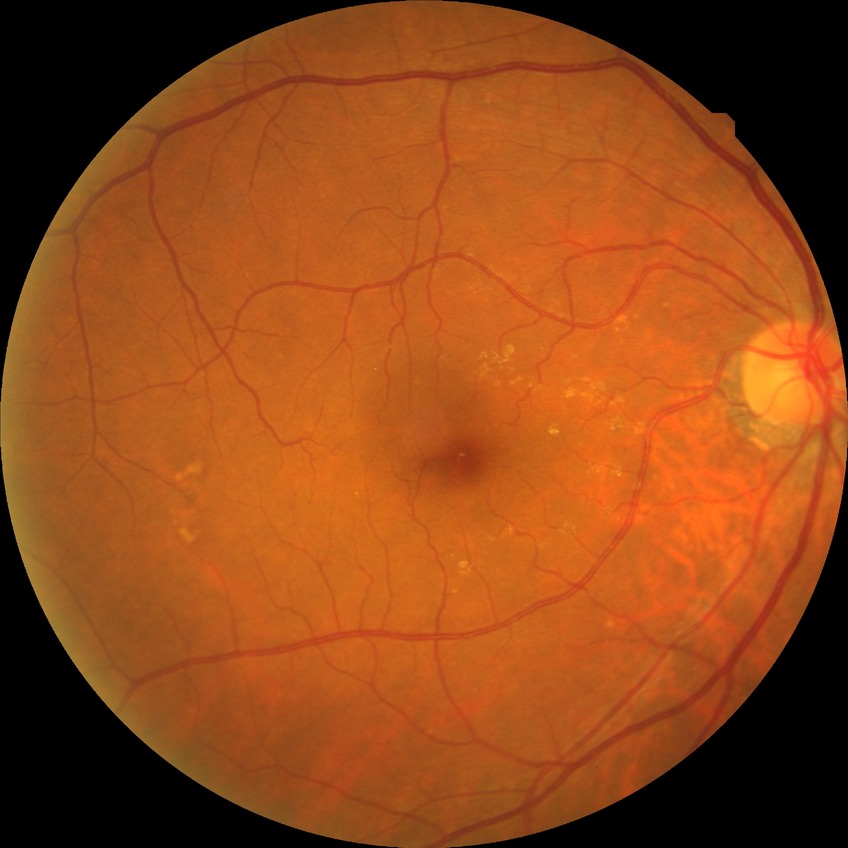

DR grade is NDR.